Diabetic retinopathy graded by the modified Davis classification: 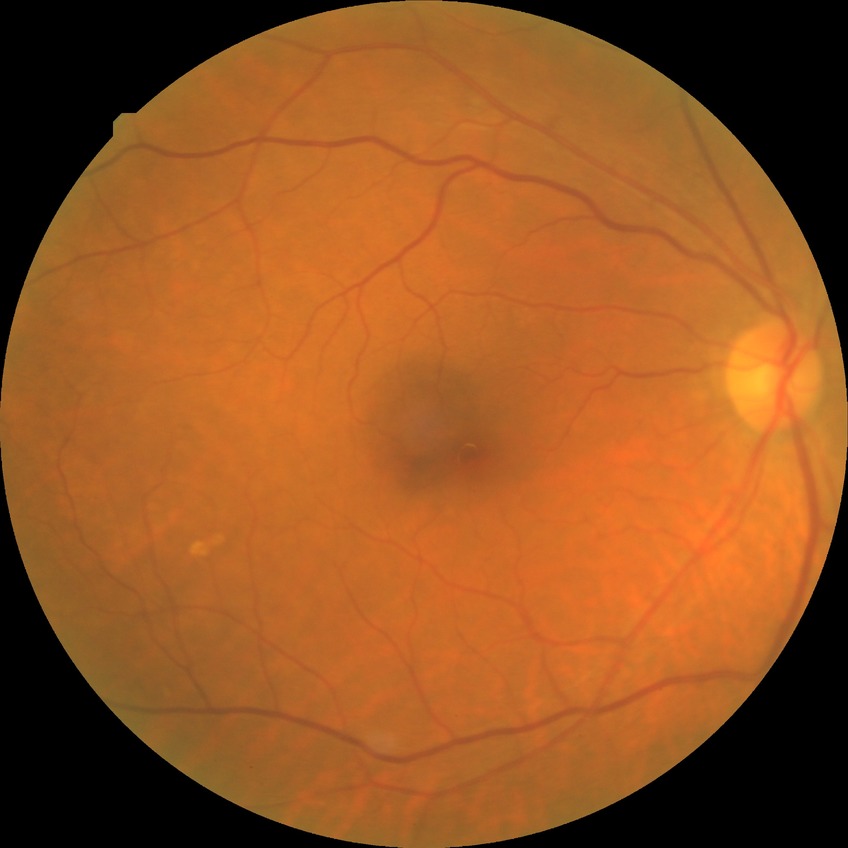 Diabetic retinopathy (DR) is NDR (no diabetic retinopathy).